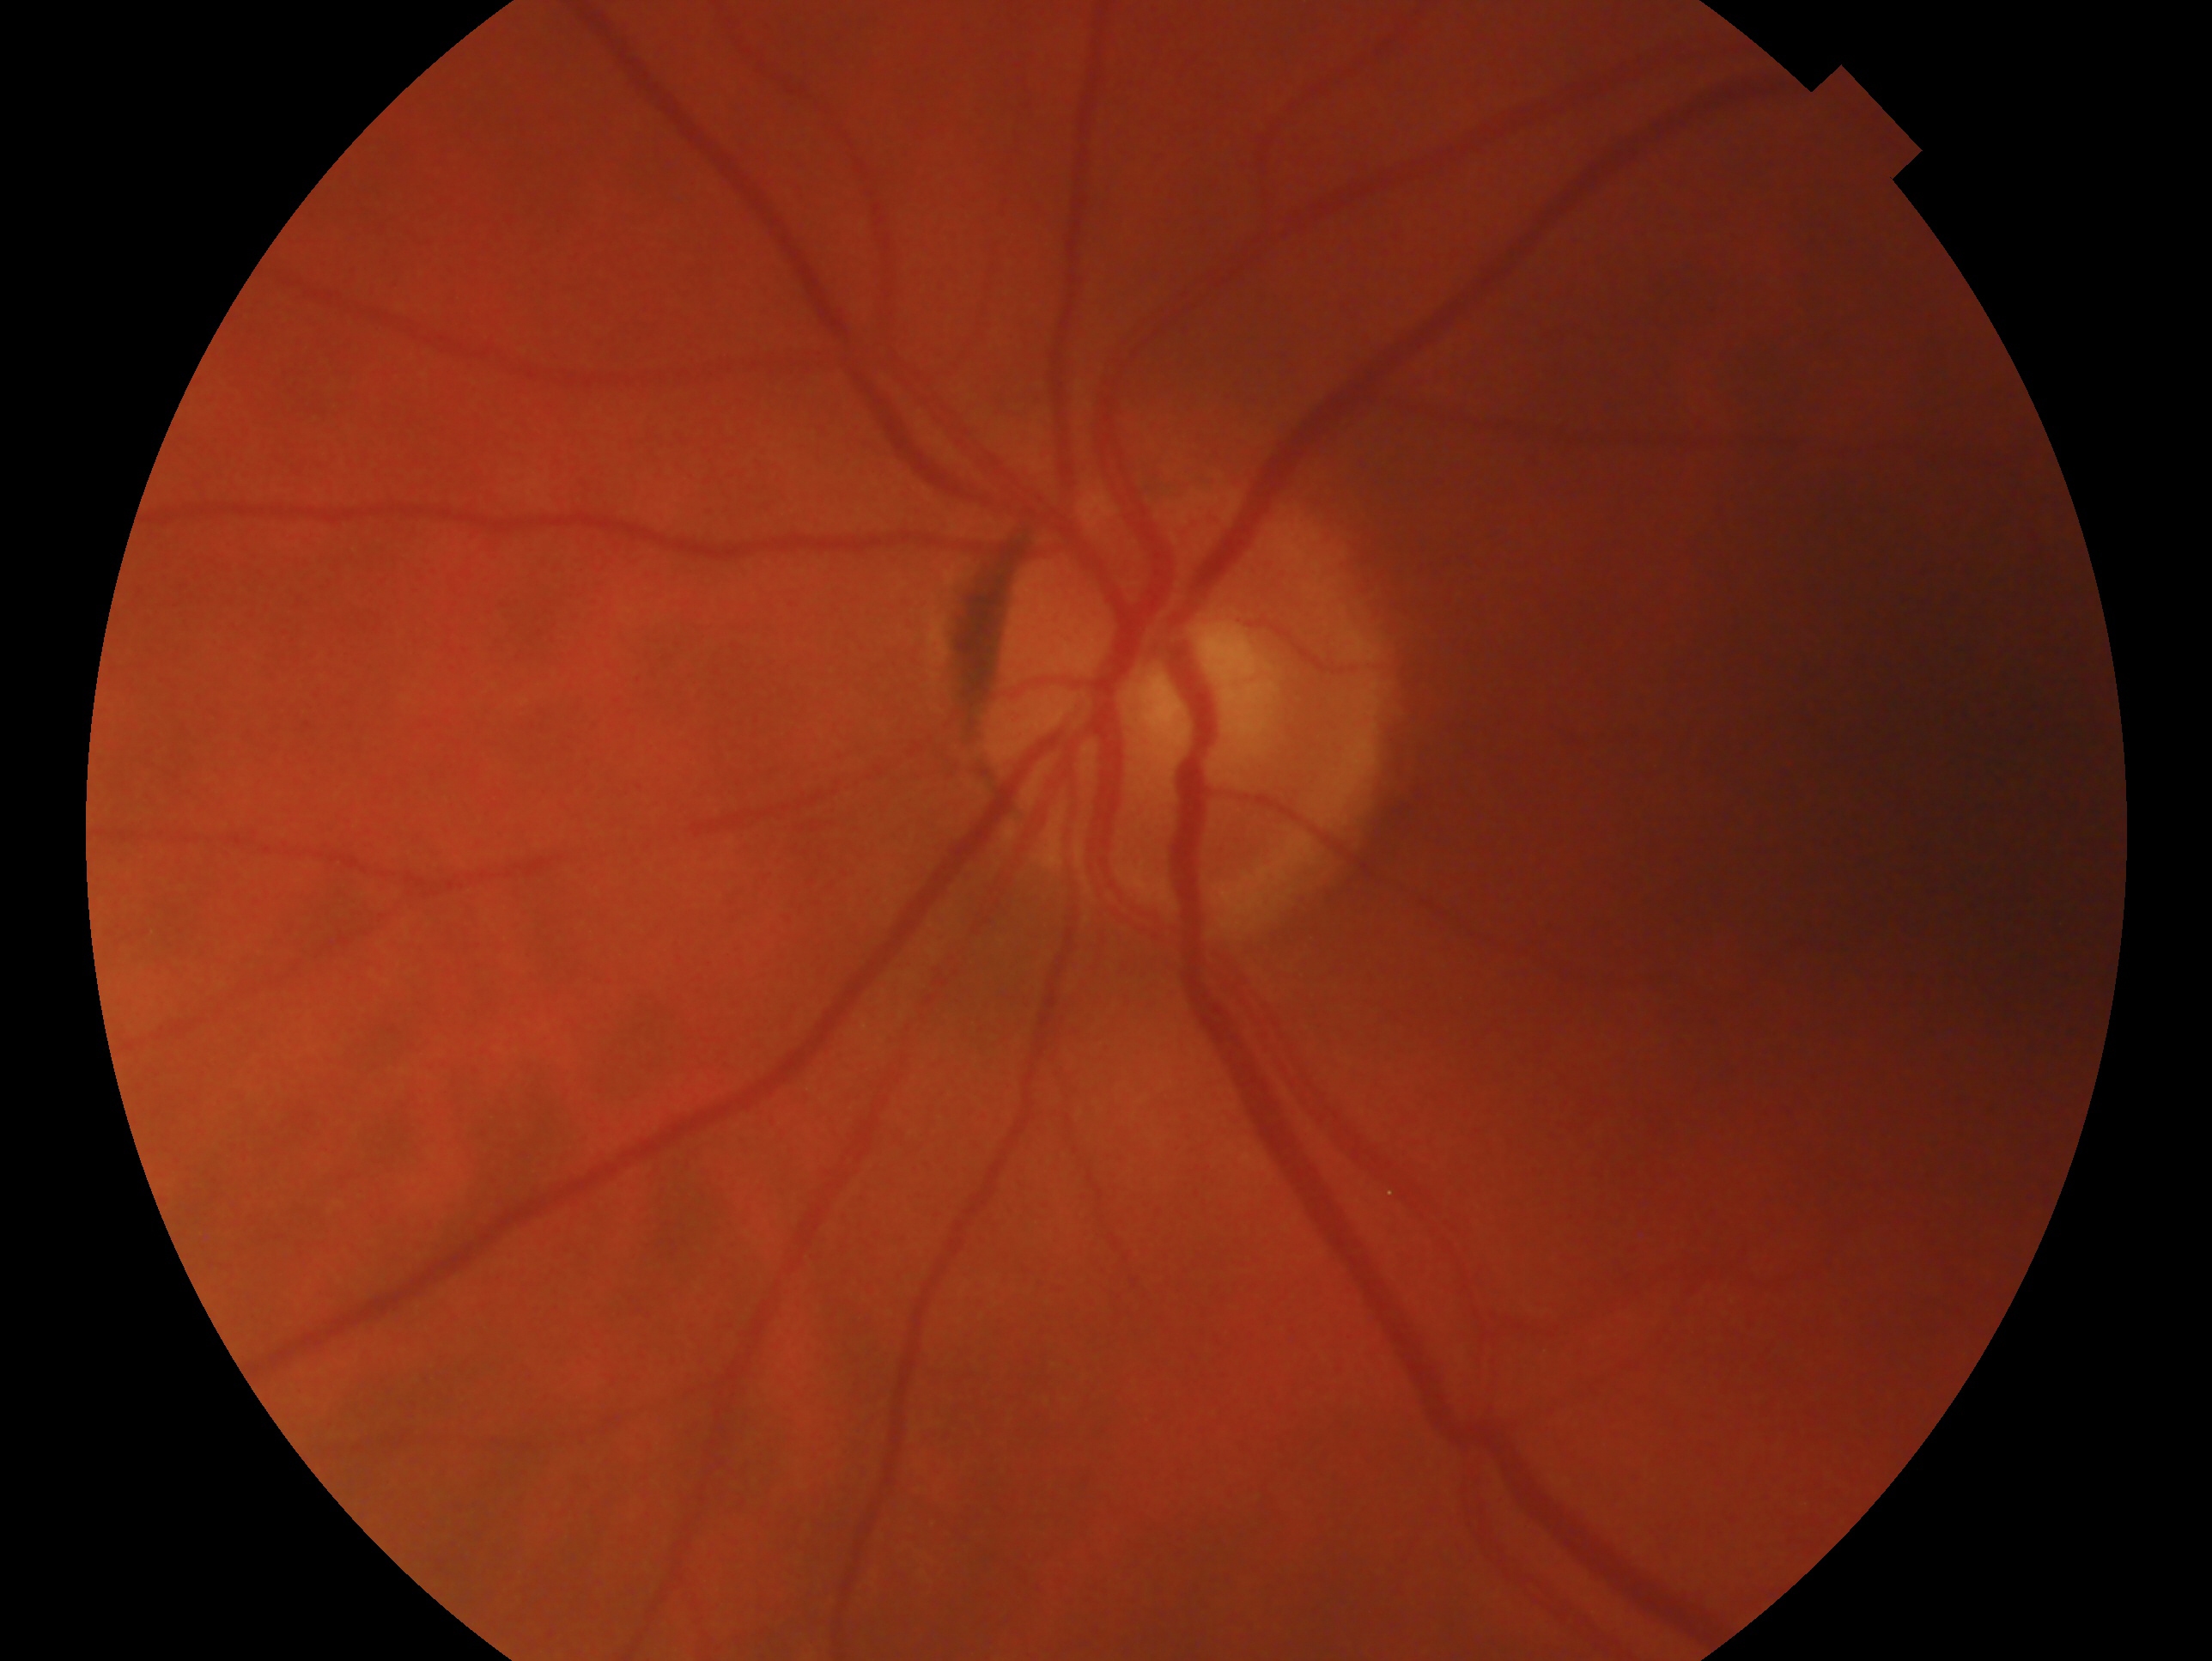
This is the OS. Clinical classification — no signs of glaucoma.